Color fundus image
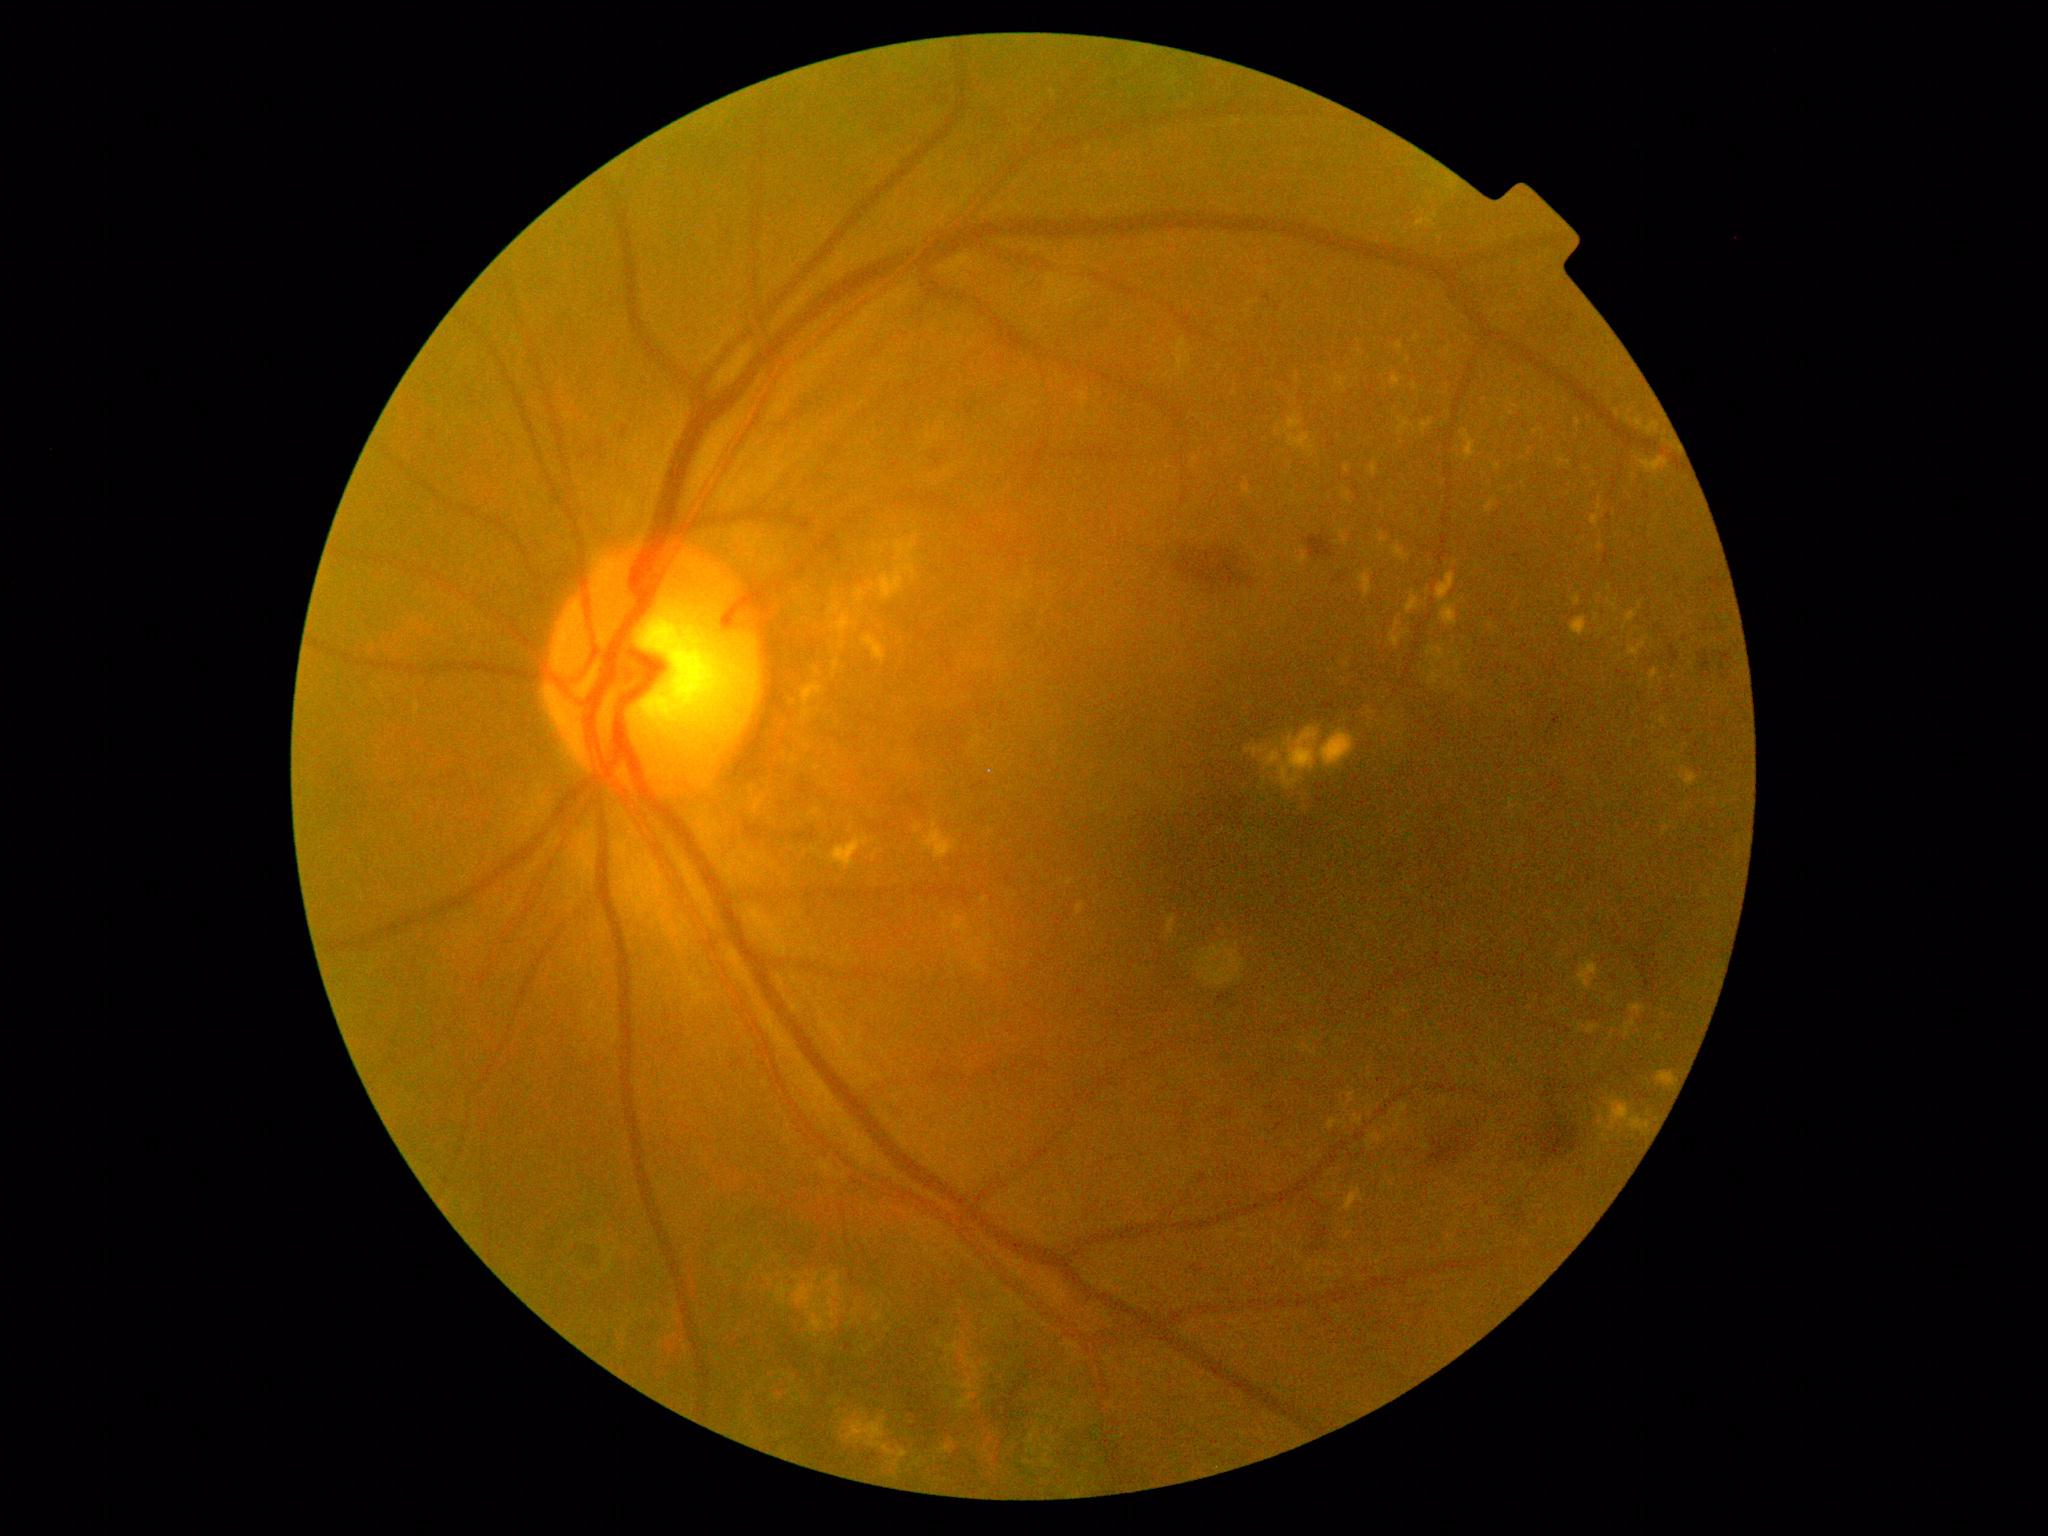 {"partial": true, "dr_grade": 2, "dr_grade_name": "moderate NPDR", "lesions": {"ex": [[1460, 430, 1477, 461], [1608, 600, 1618, 613], [1651, 669, 1659, 682], [1358, 571, 1373, 599], [1407, 590, 1421, 614], [1066, 879, 1075, 885], [1639, 601, 1642, 610], [1599, 1097, 1652, 1136], [828, 603, 841, 616], [1420, 420, 1434, 434], [1384, 1127, 1393, 1136], [1590, 514, 1602, 527], [863, 636, 887, 664], [1345, 465, 1350, 473], [1367, 1133, 1383, 1150], [1625, 1020, 1638, 1038]], "ex_small_approx": [[888, 543], [861, 612], [1544, 432]]}}